100° field of view (Phoenix ICON). Pediatric wide-field fundus photograph
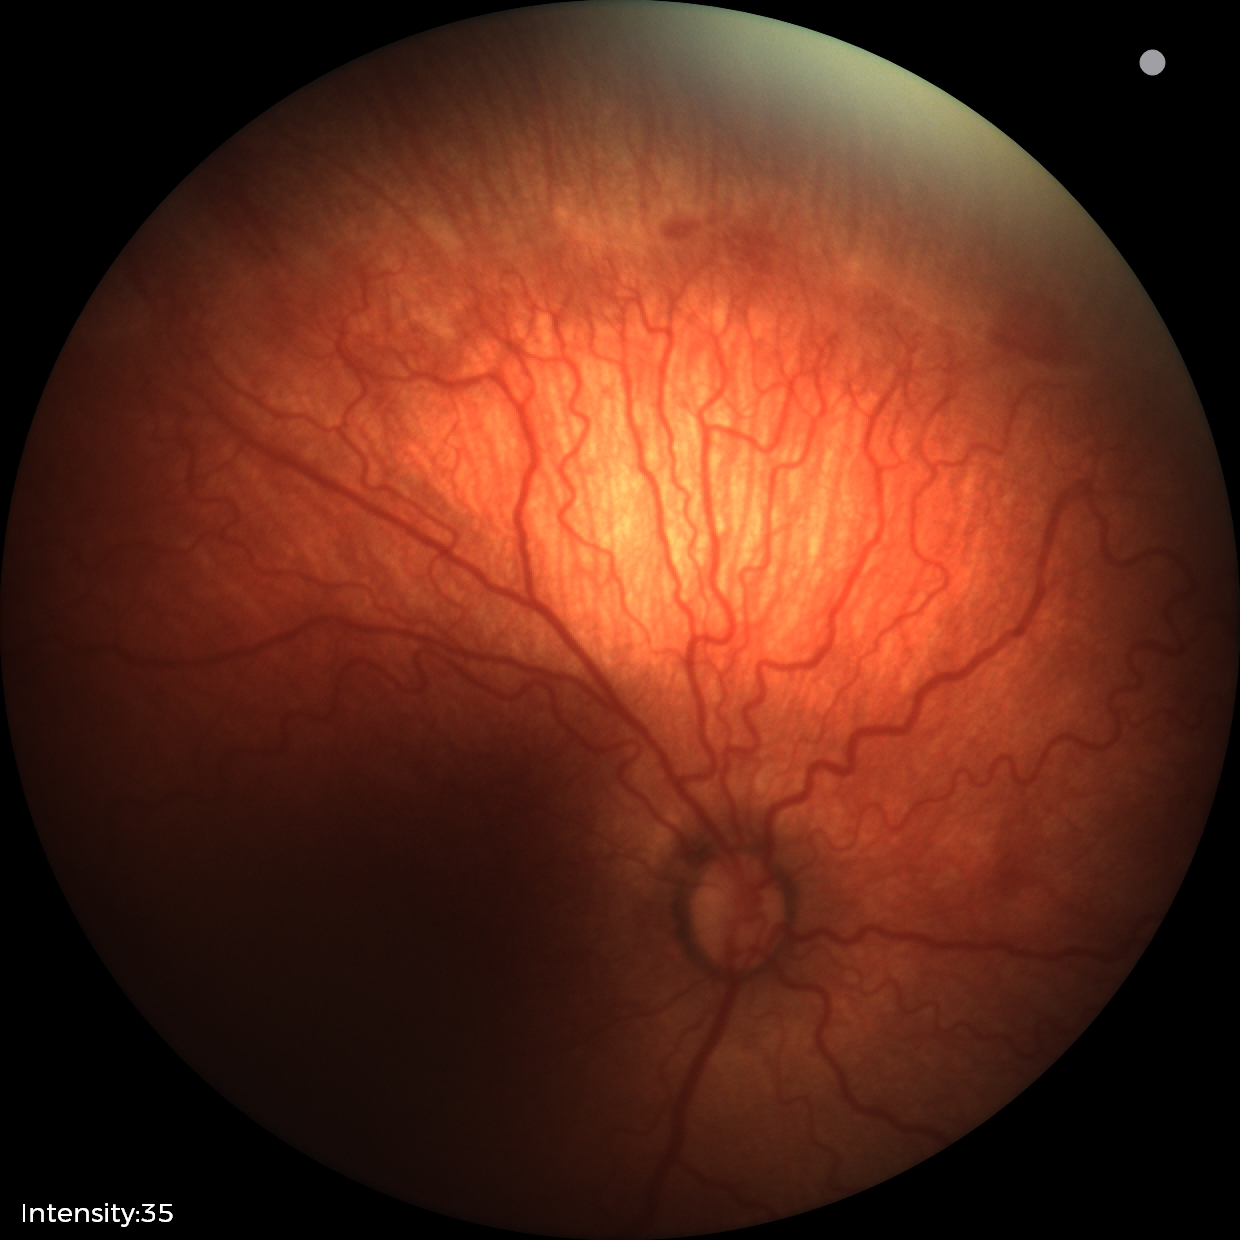 Screening diagnosis: ROP stage 2.